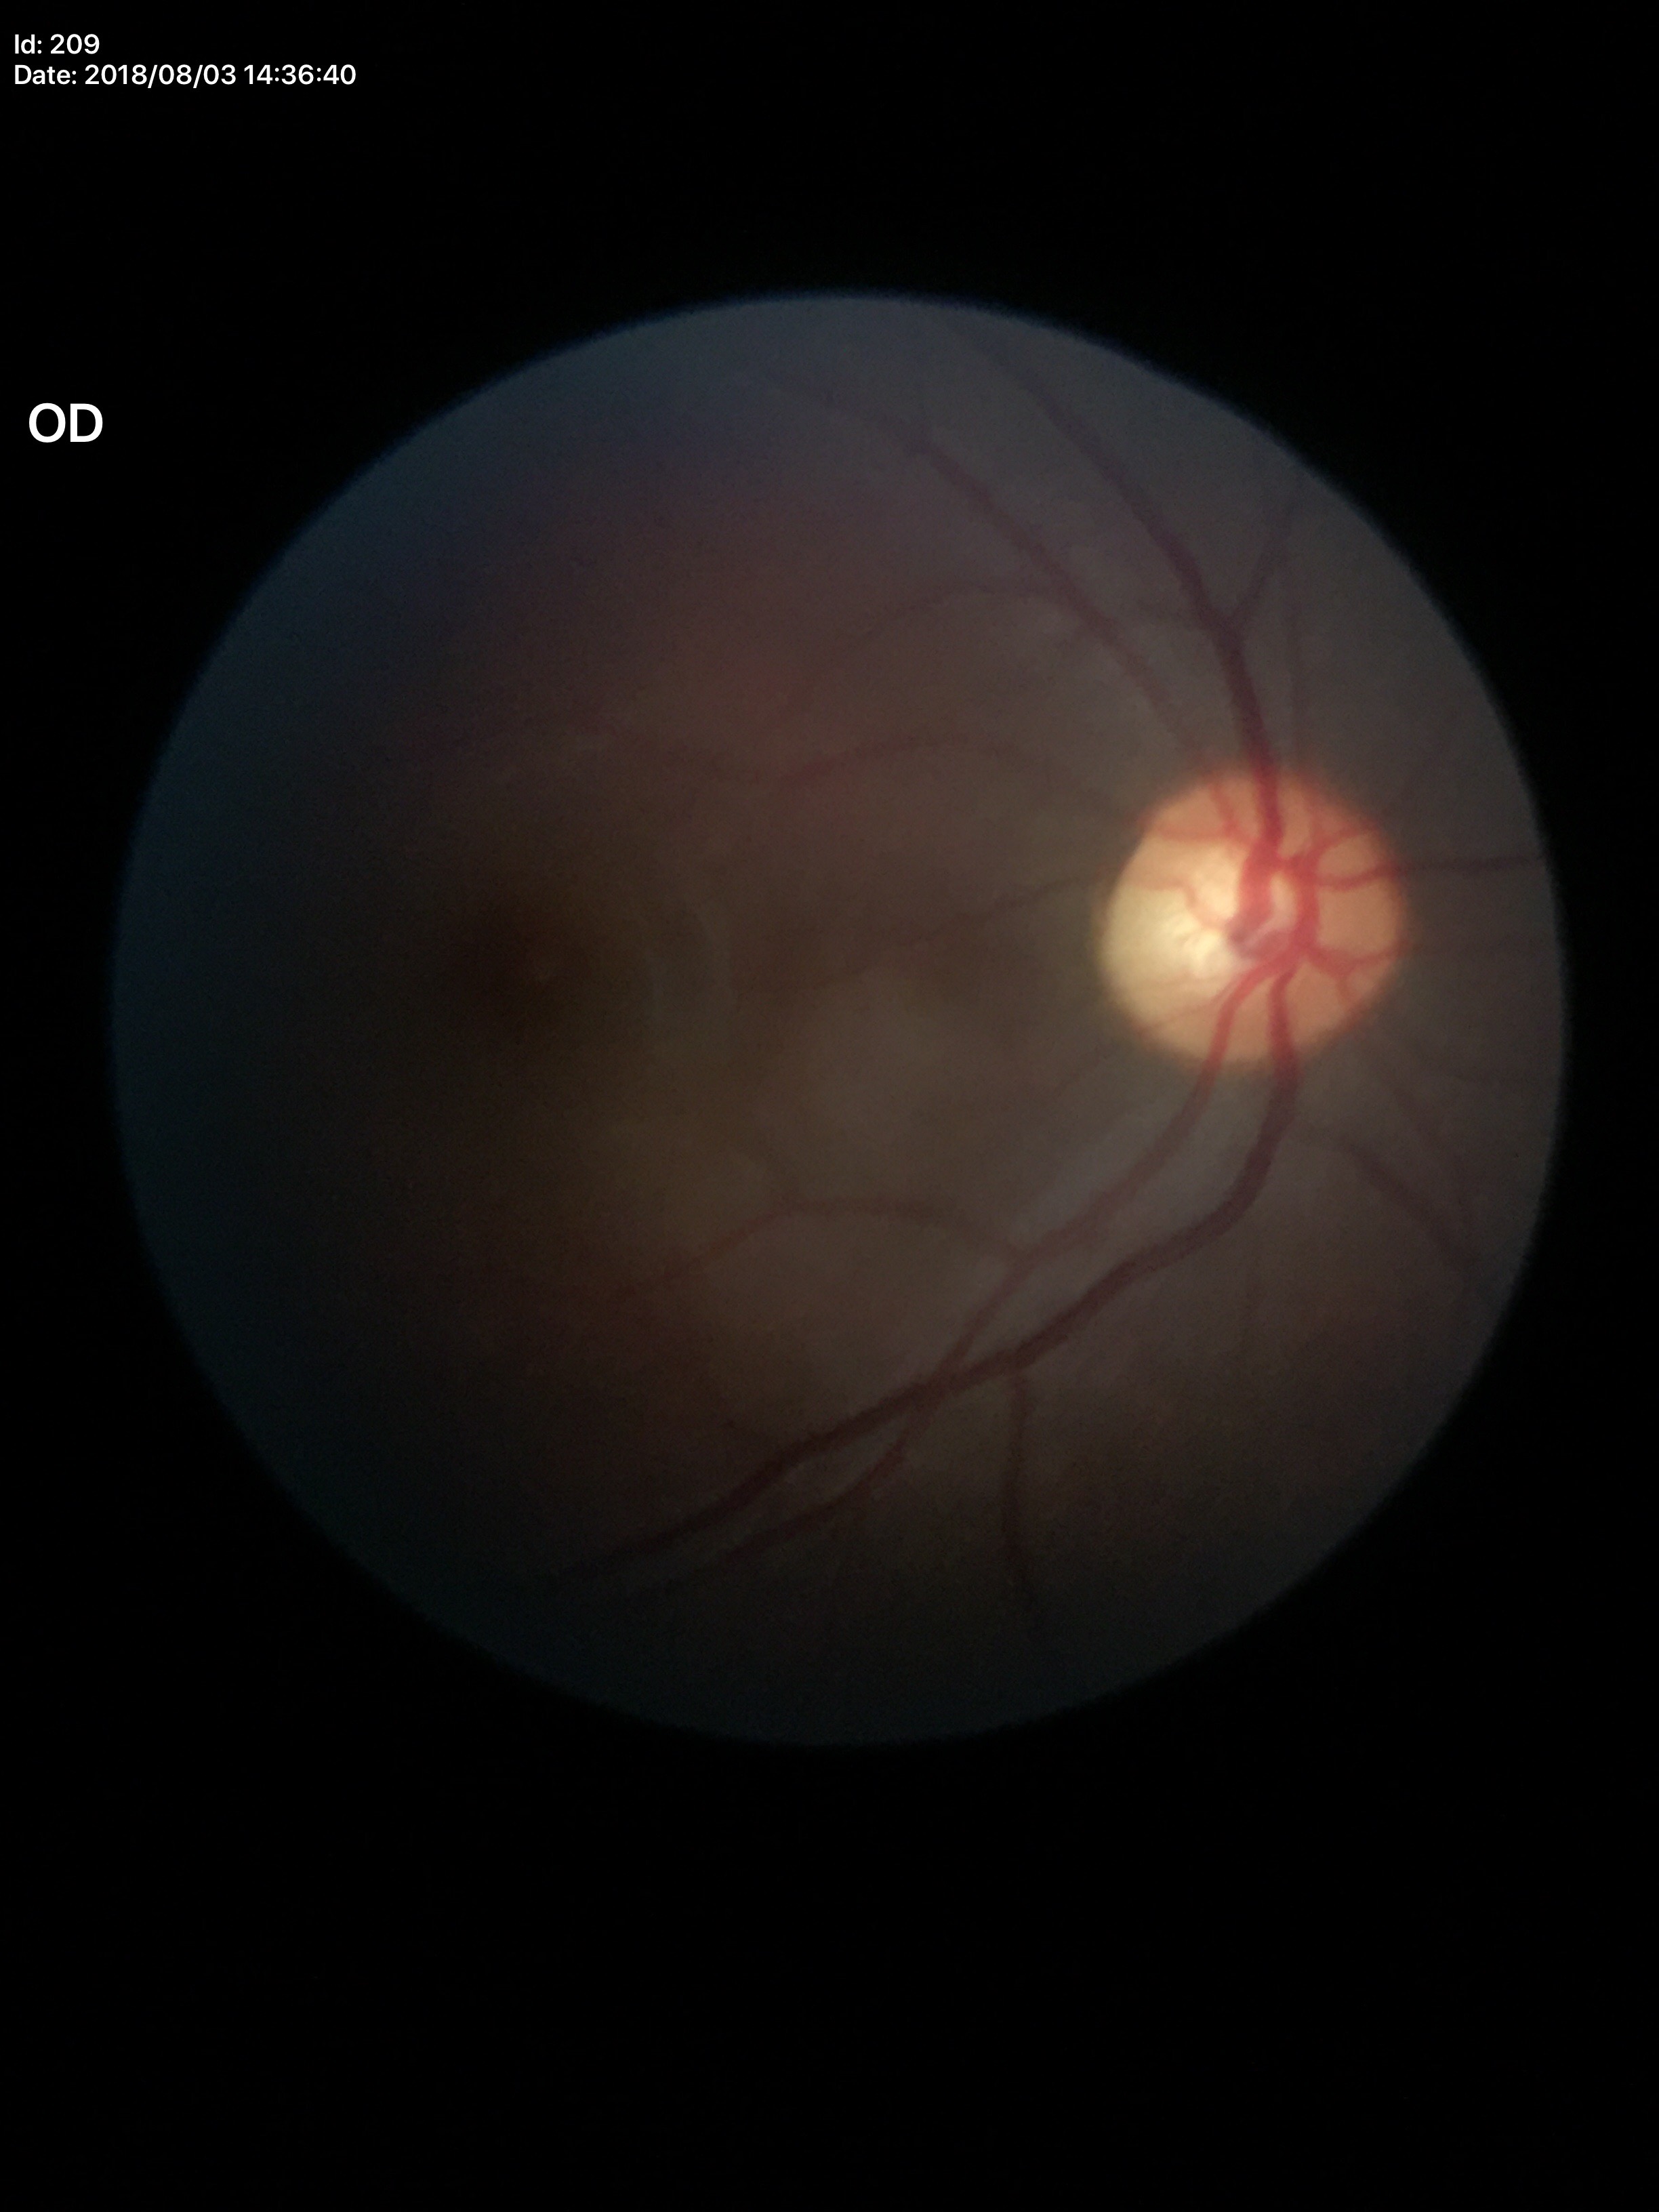
Glaucoma assessment: negative. Horizontal cup-to-disc ratio (HCDR) is 0.56. Vertical CDR (VCDR) is 0.56.